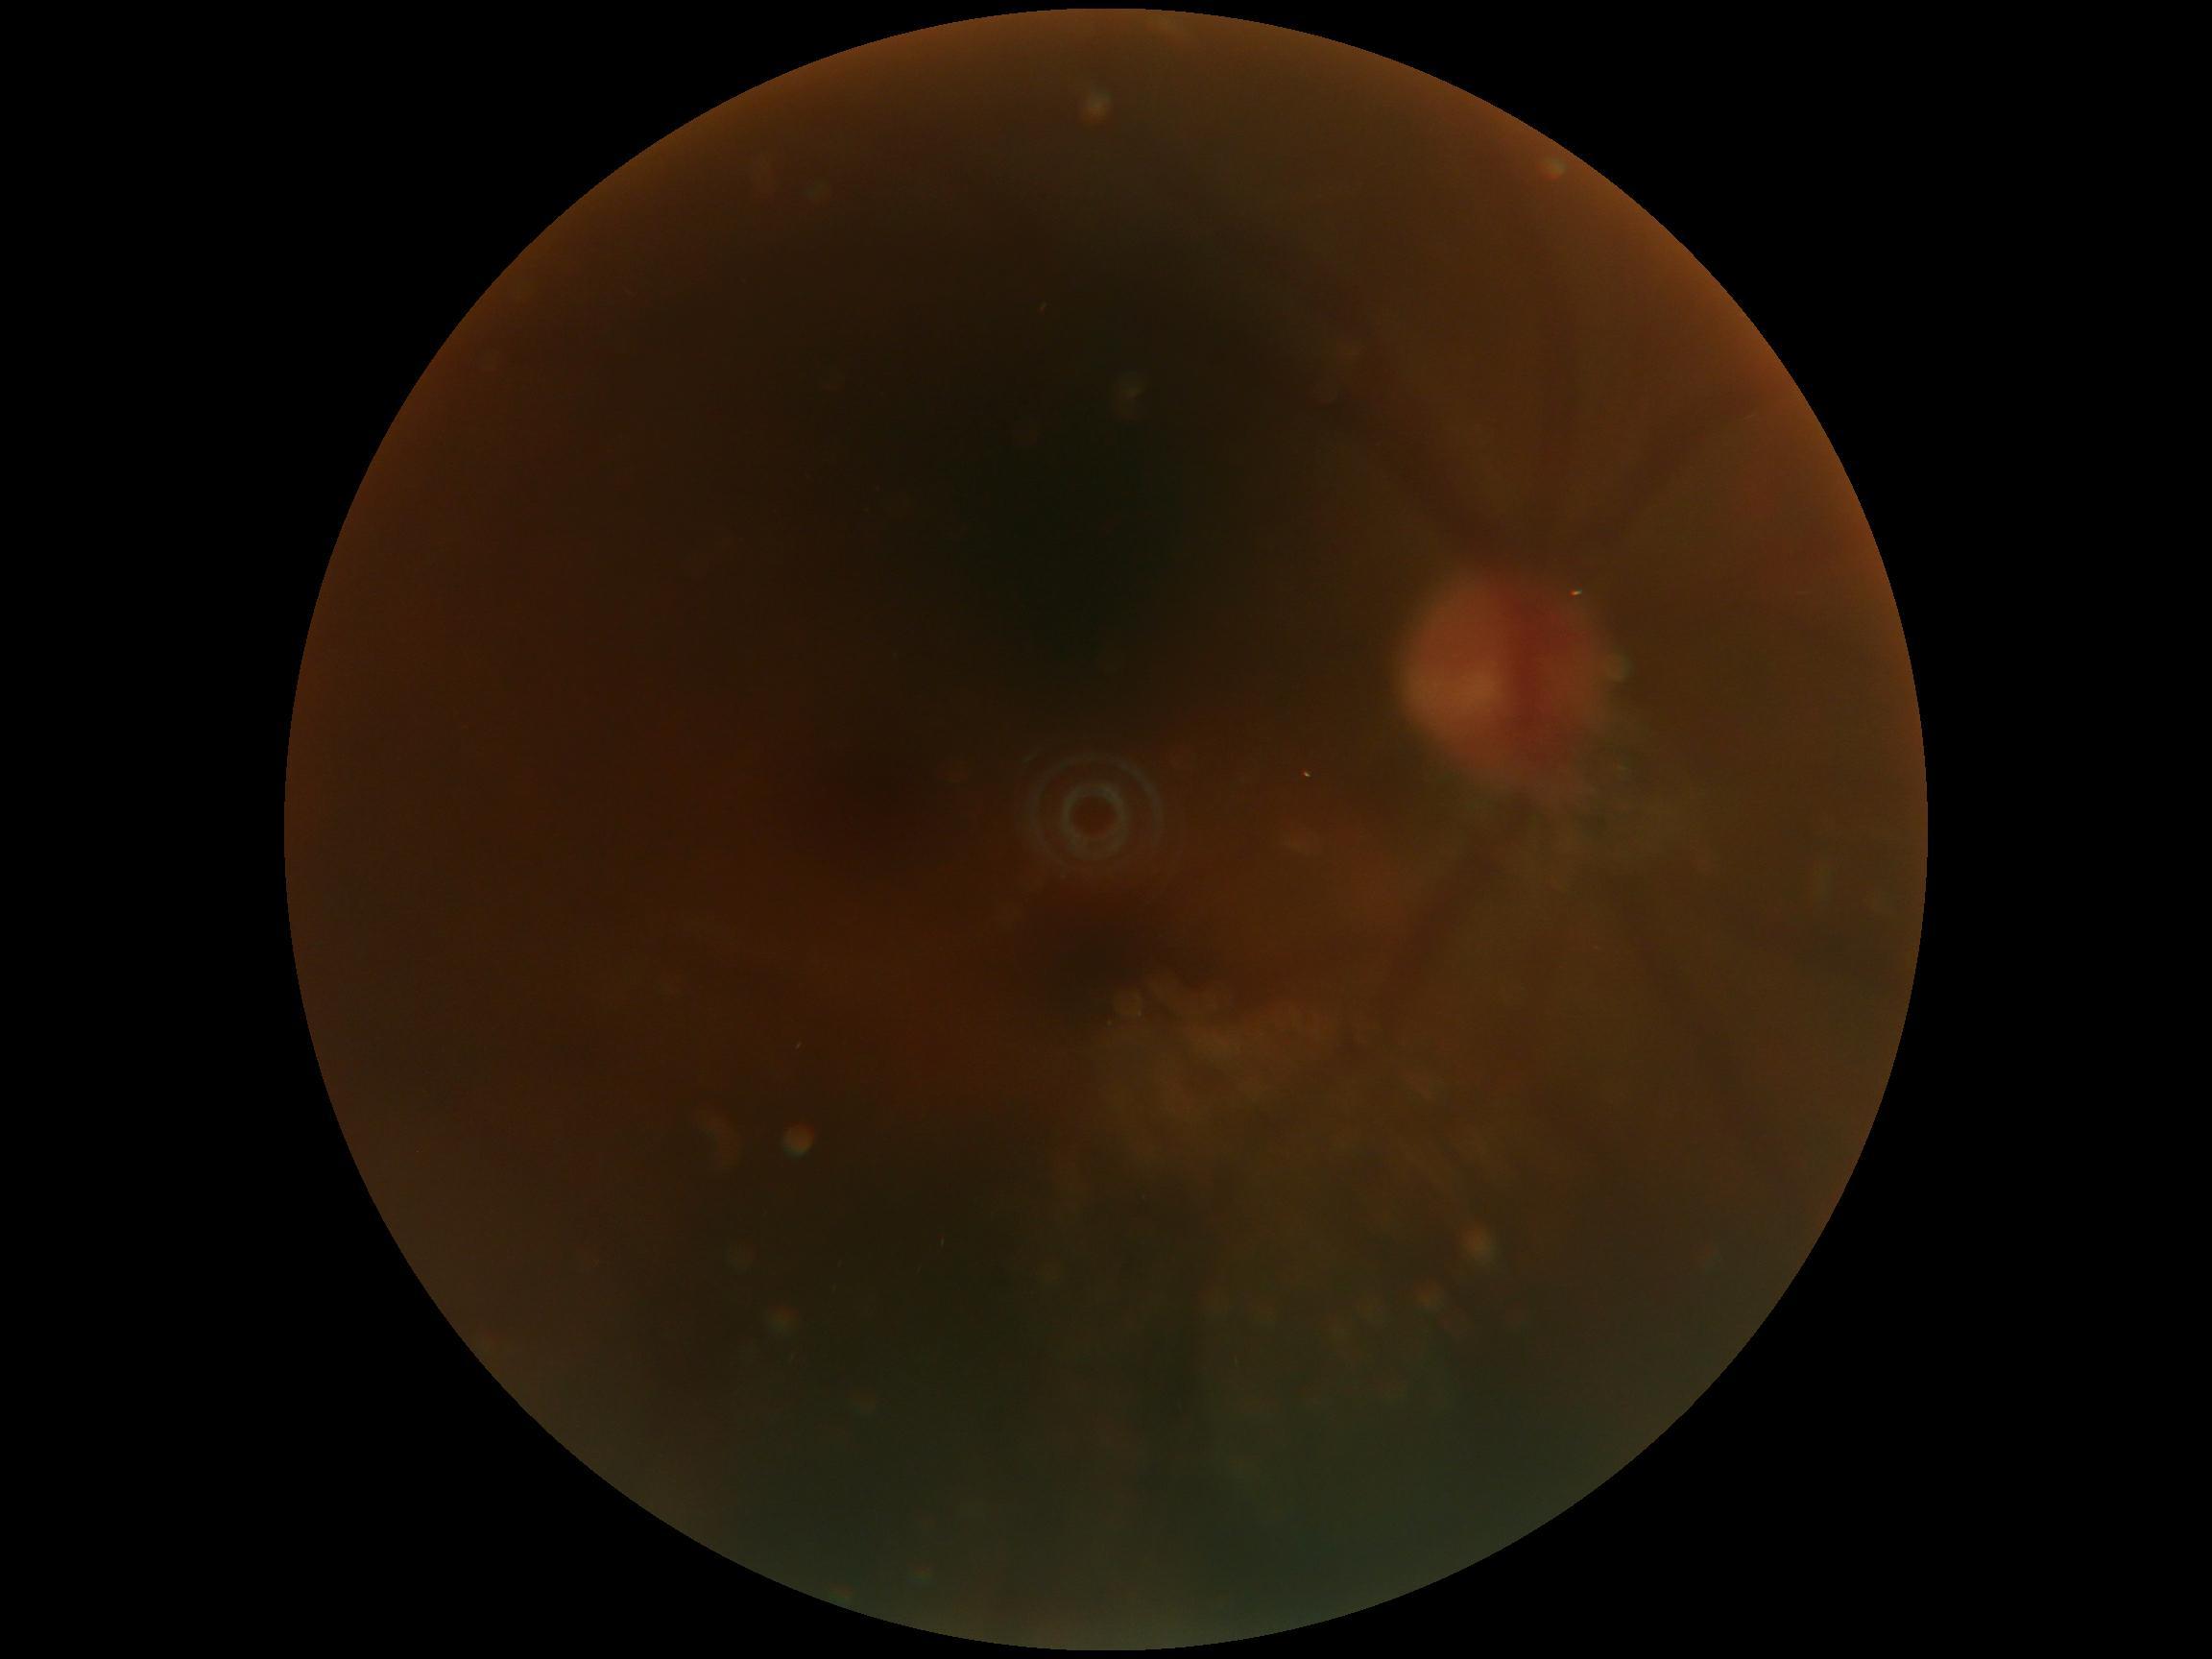
* image quality: below grading threshold
* DR stage: ungradable